Captured with the Phoenix ICON (100° field of view); wide-field contact fundus photograph of an infant.
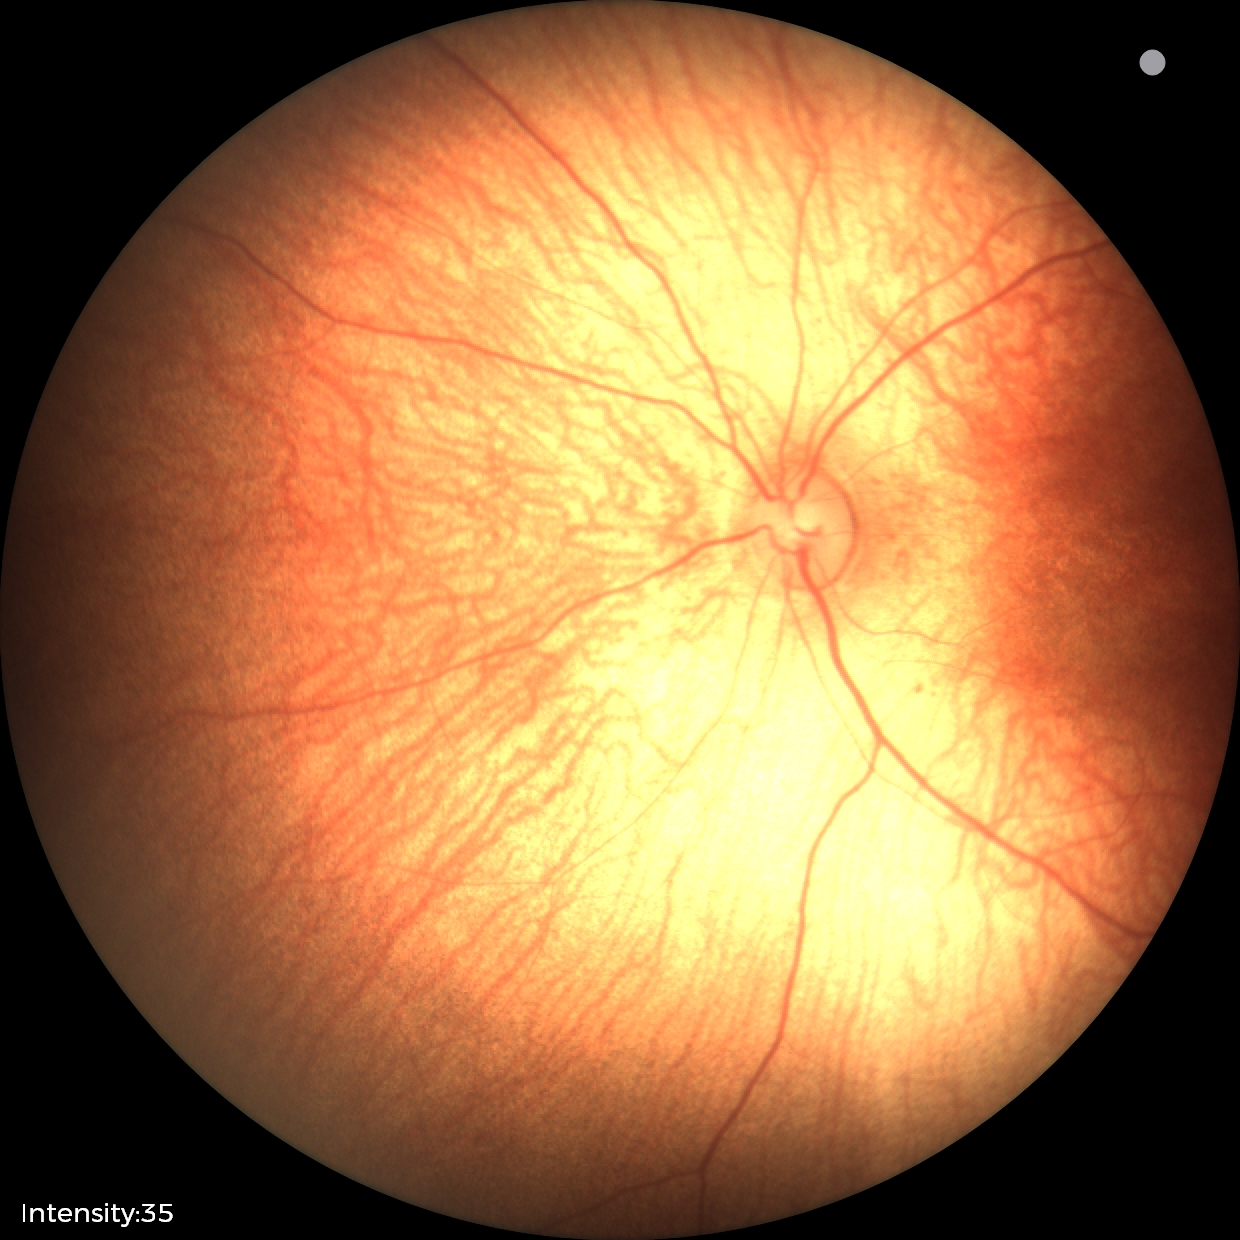

Normal screening examination.